Pediatric wide-field fundus photograph. 1240 x 1240 pixels:
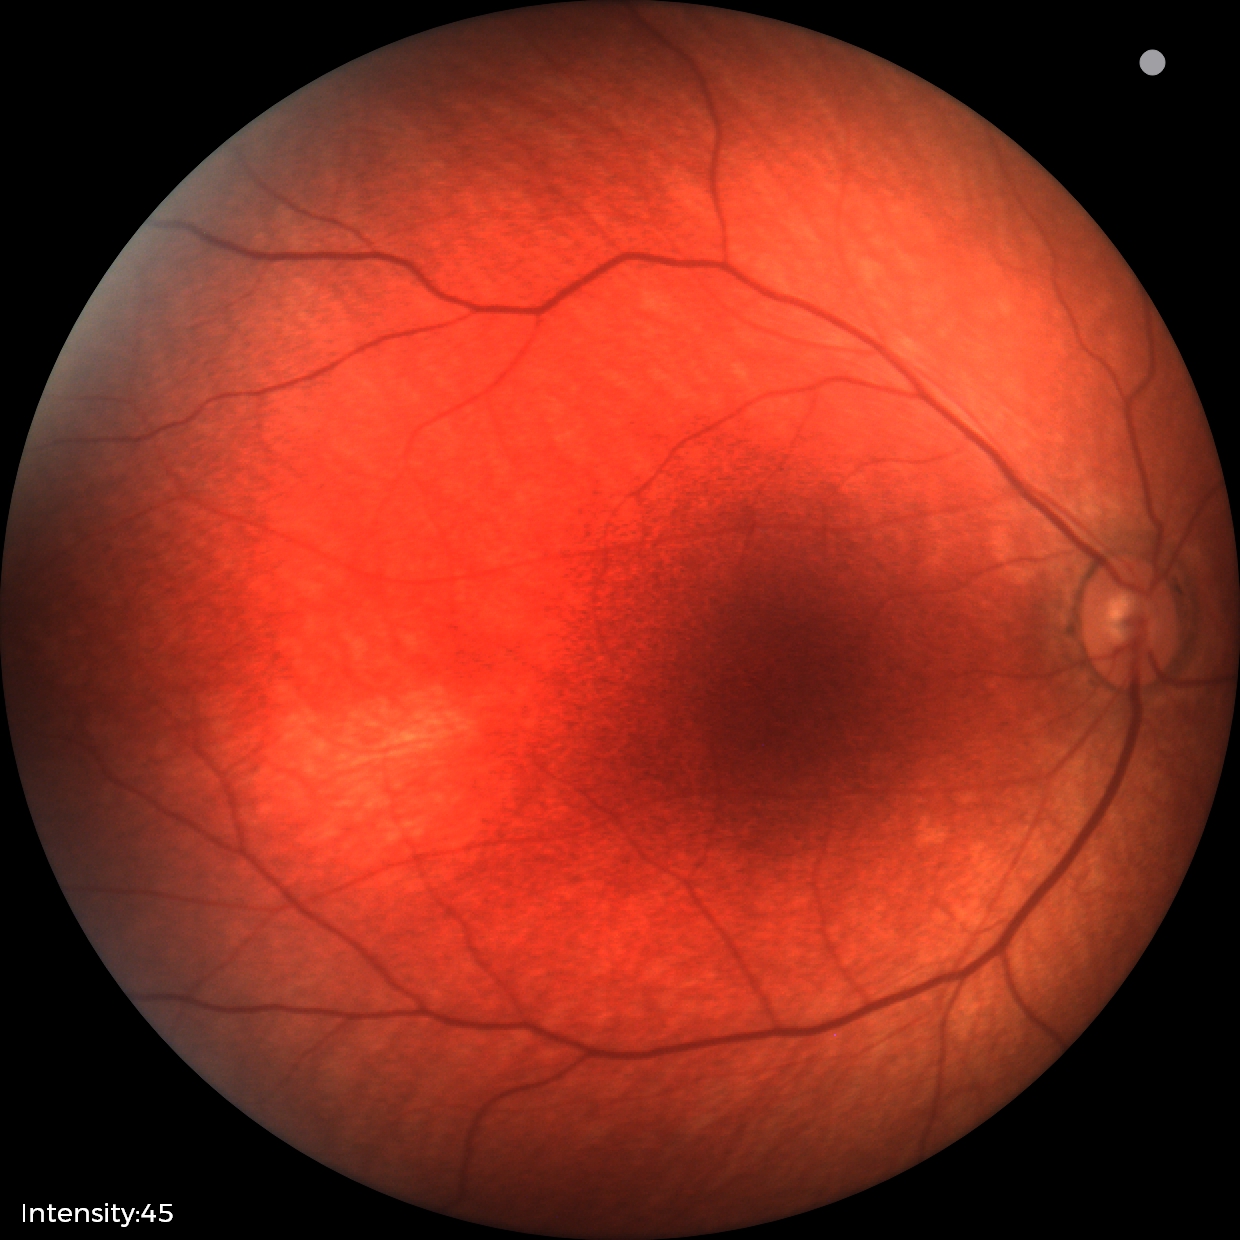
Screening diagnosis: physiological appearance with no retinal pathology.